Image size 2184x1682; color fundus image
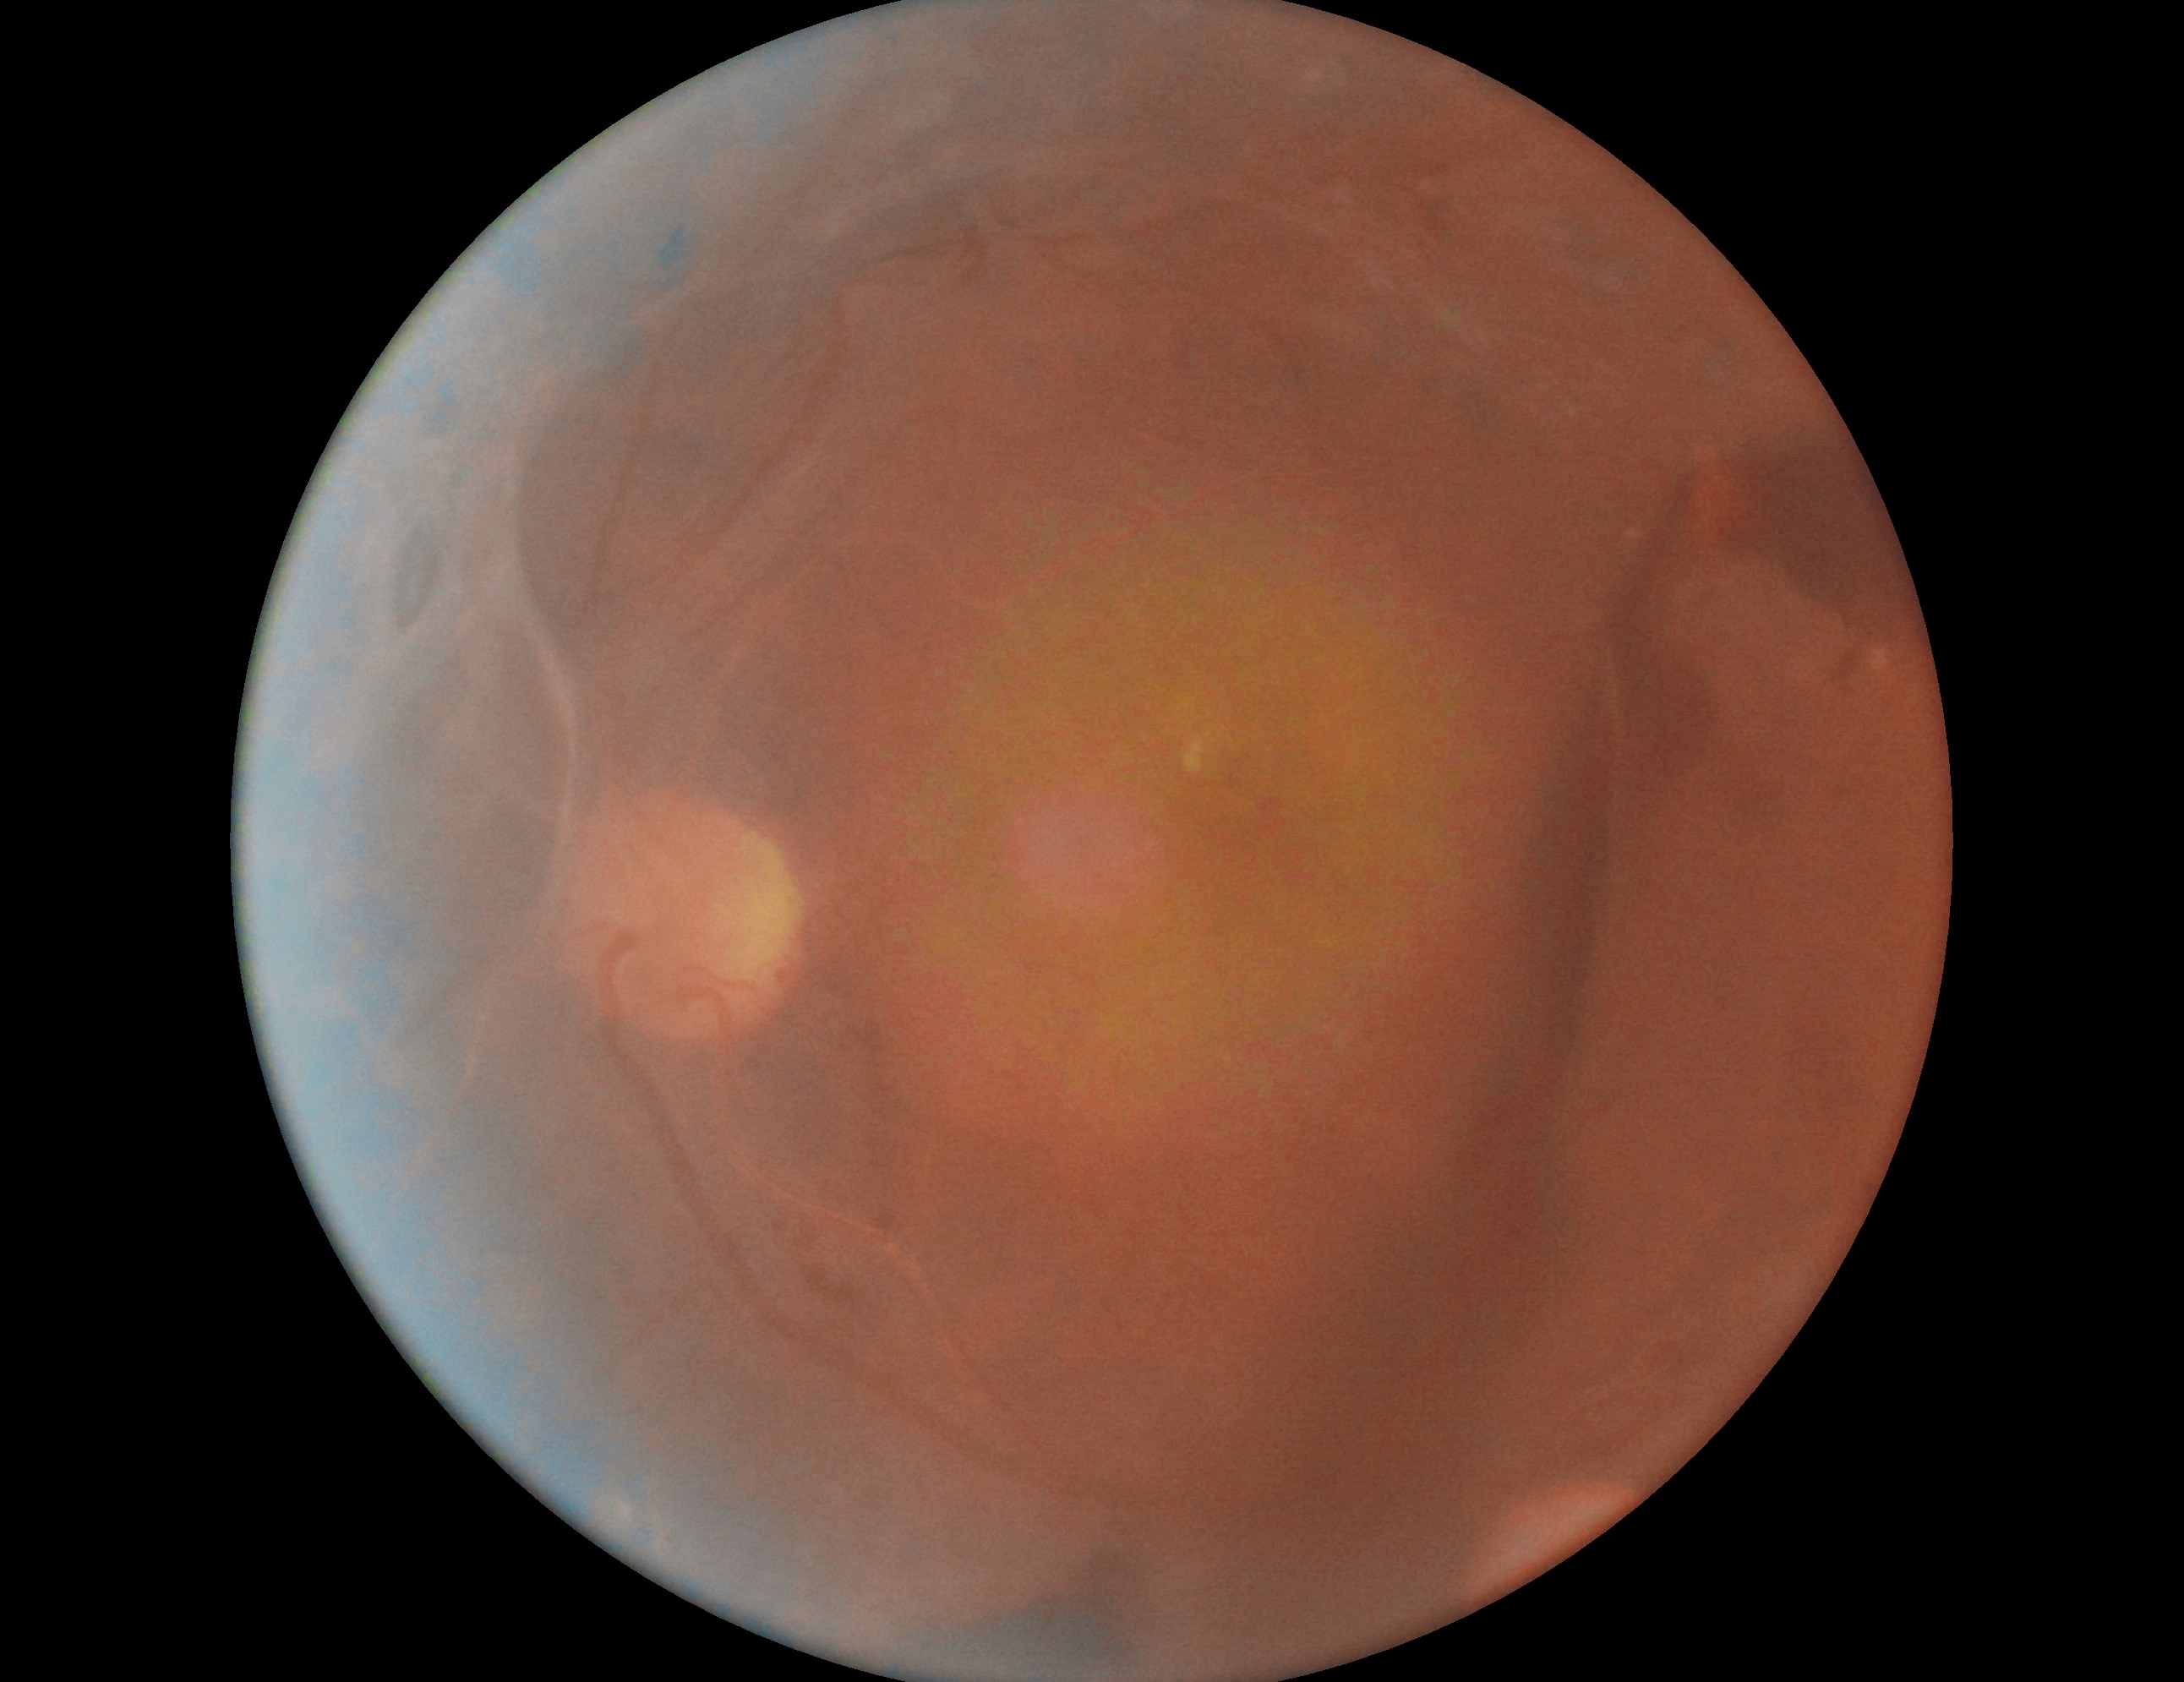 Diabetic retinopathy: 4/4.